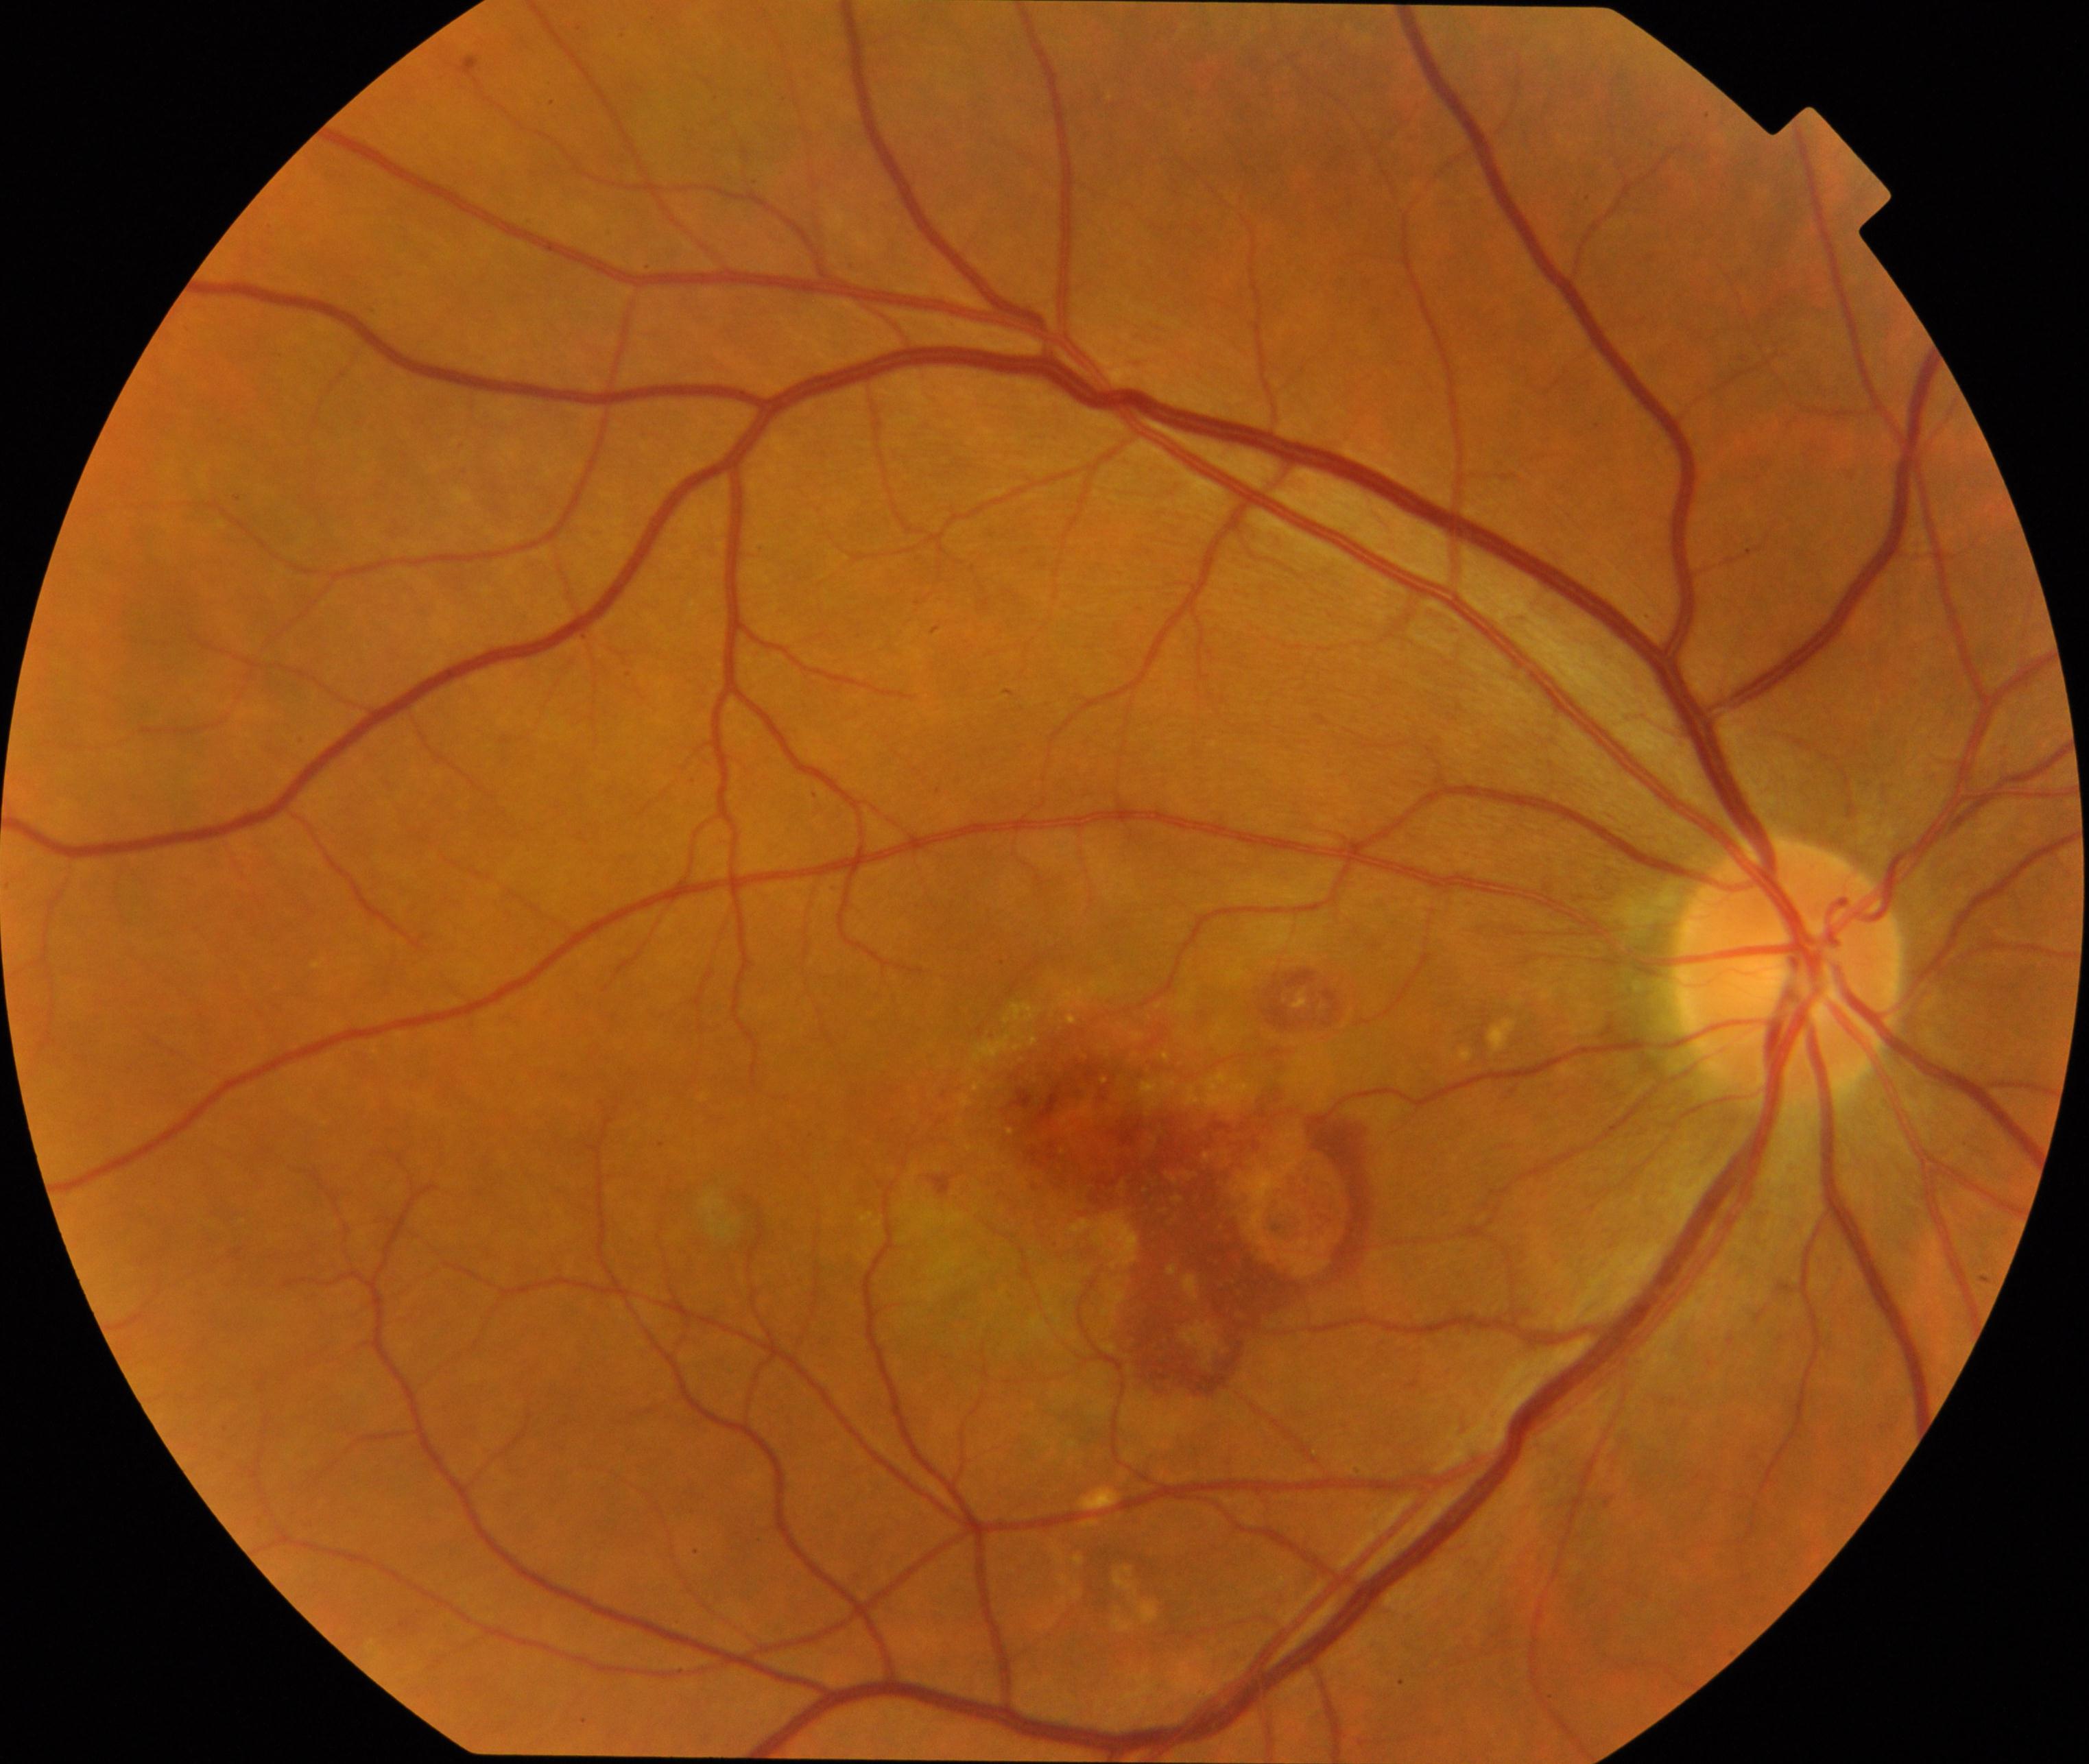 Diagnosis: maculopathy.